Fundus photo; 2048 by 1536 pixels: 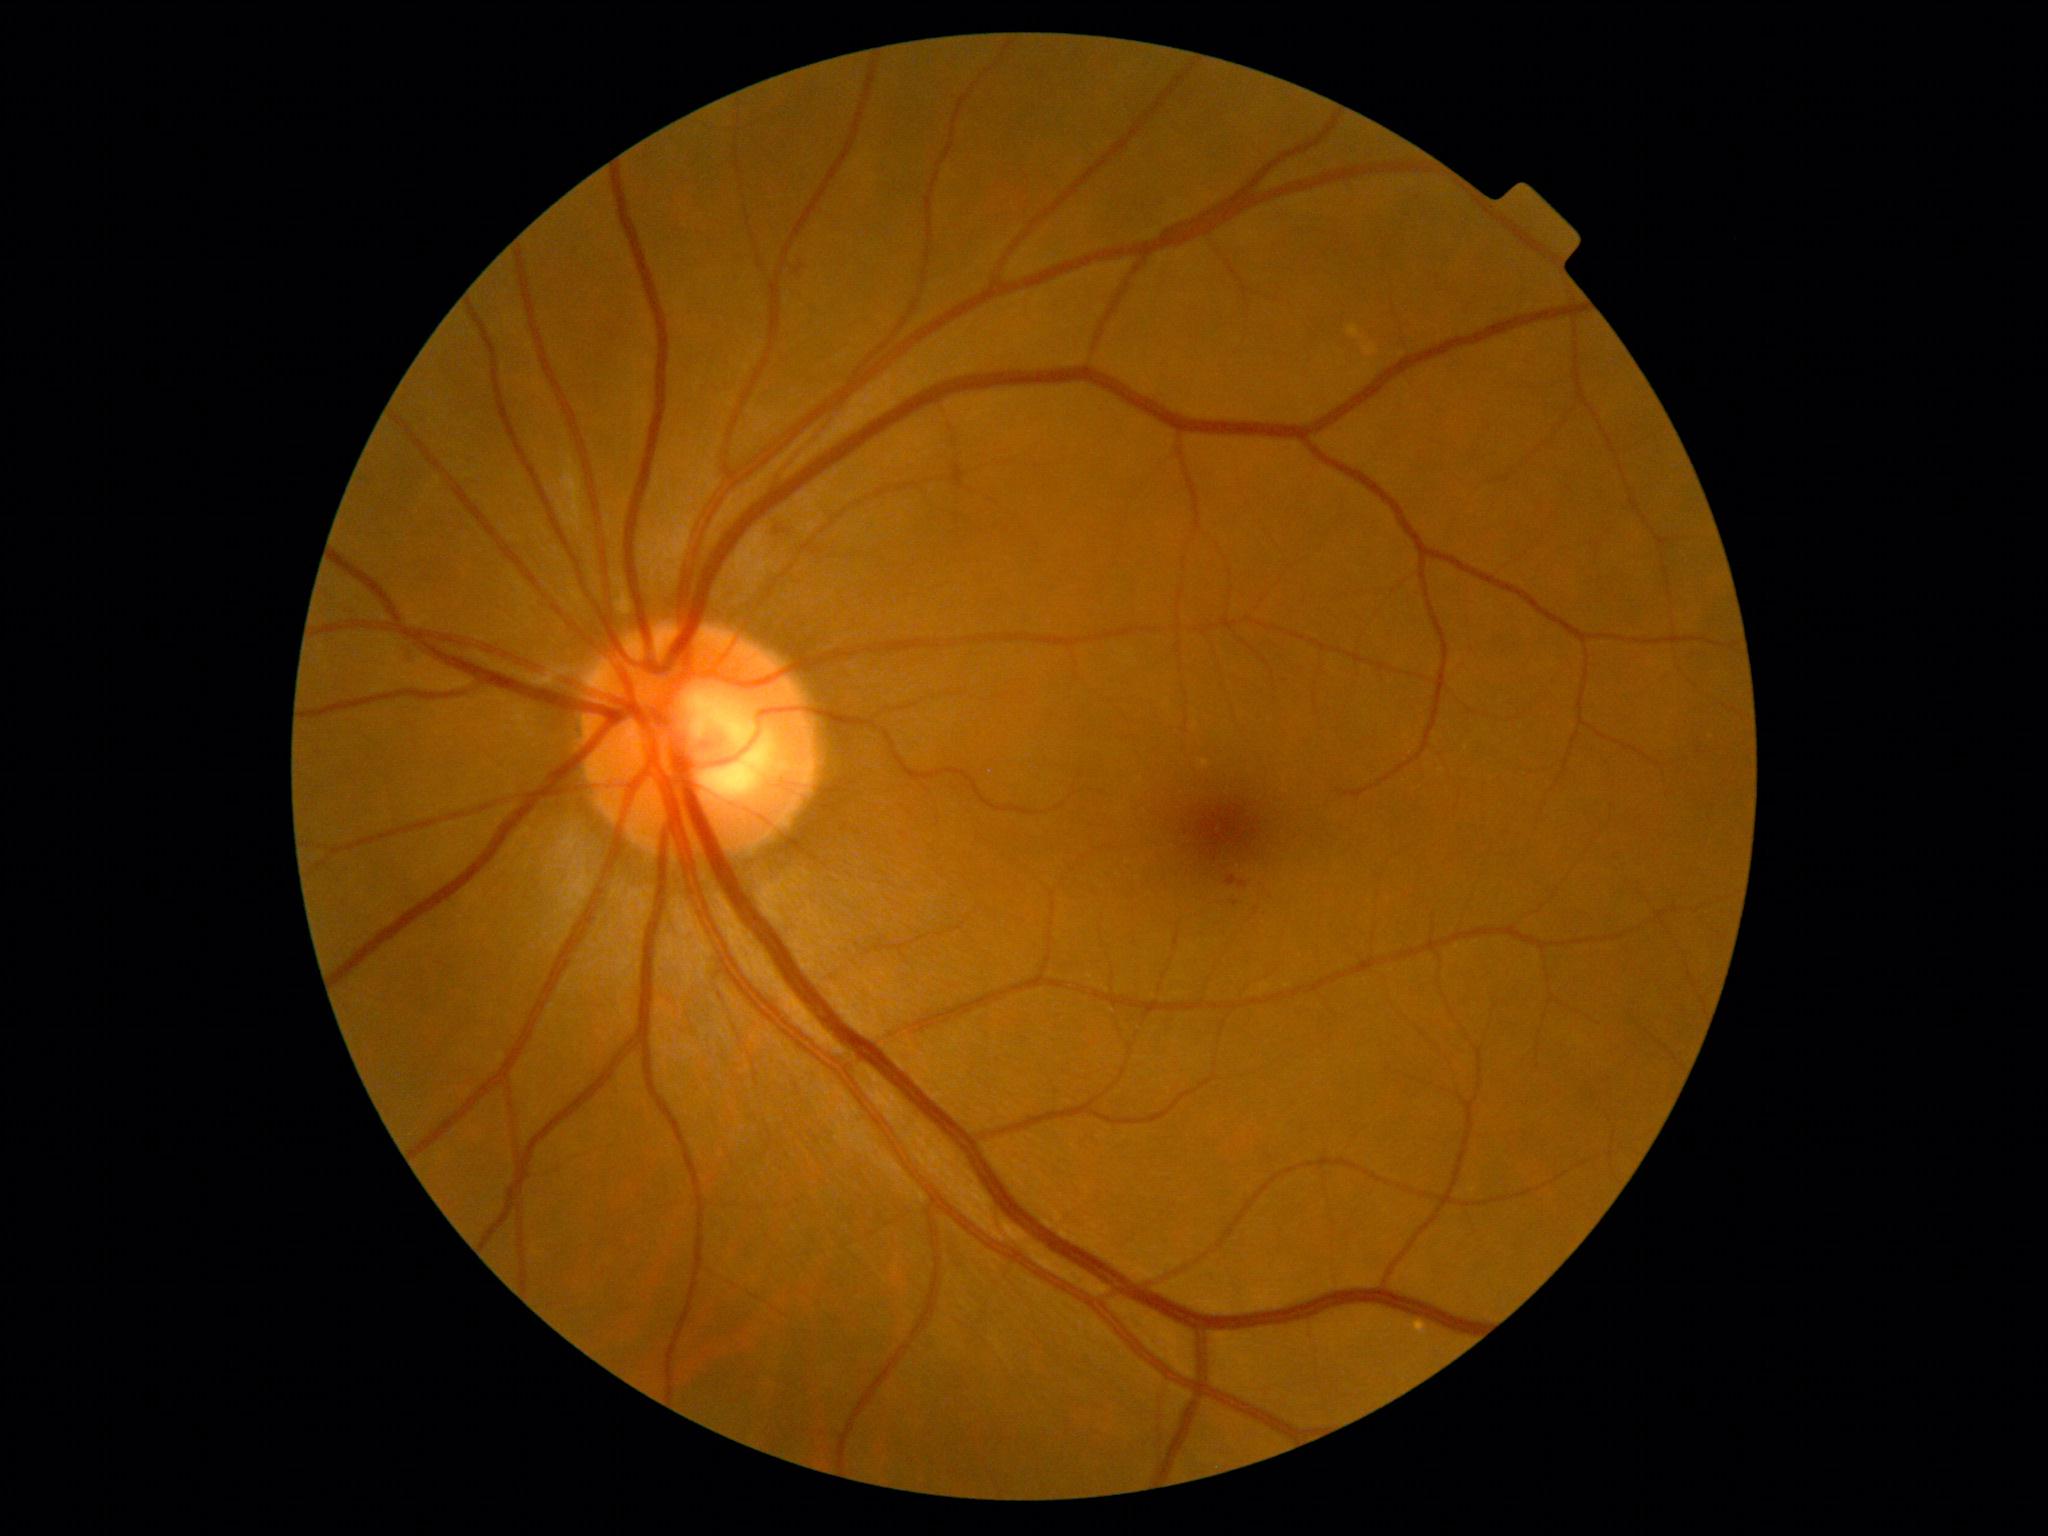
DR stage is grade 1 (mild NPDR).